Wide-field fundus image from infant ROP screening: 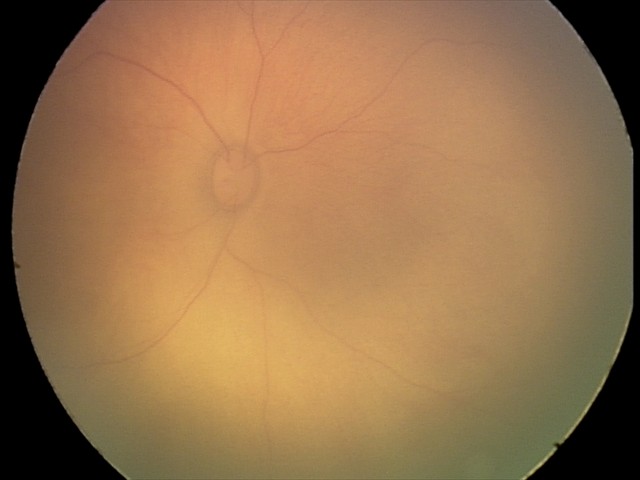 Impression: retinal hemorrhages